Image size 2048x1536:
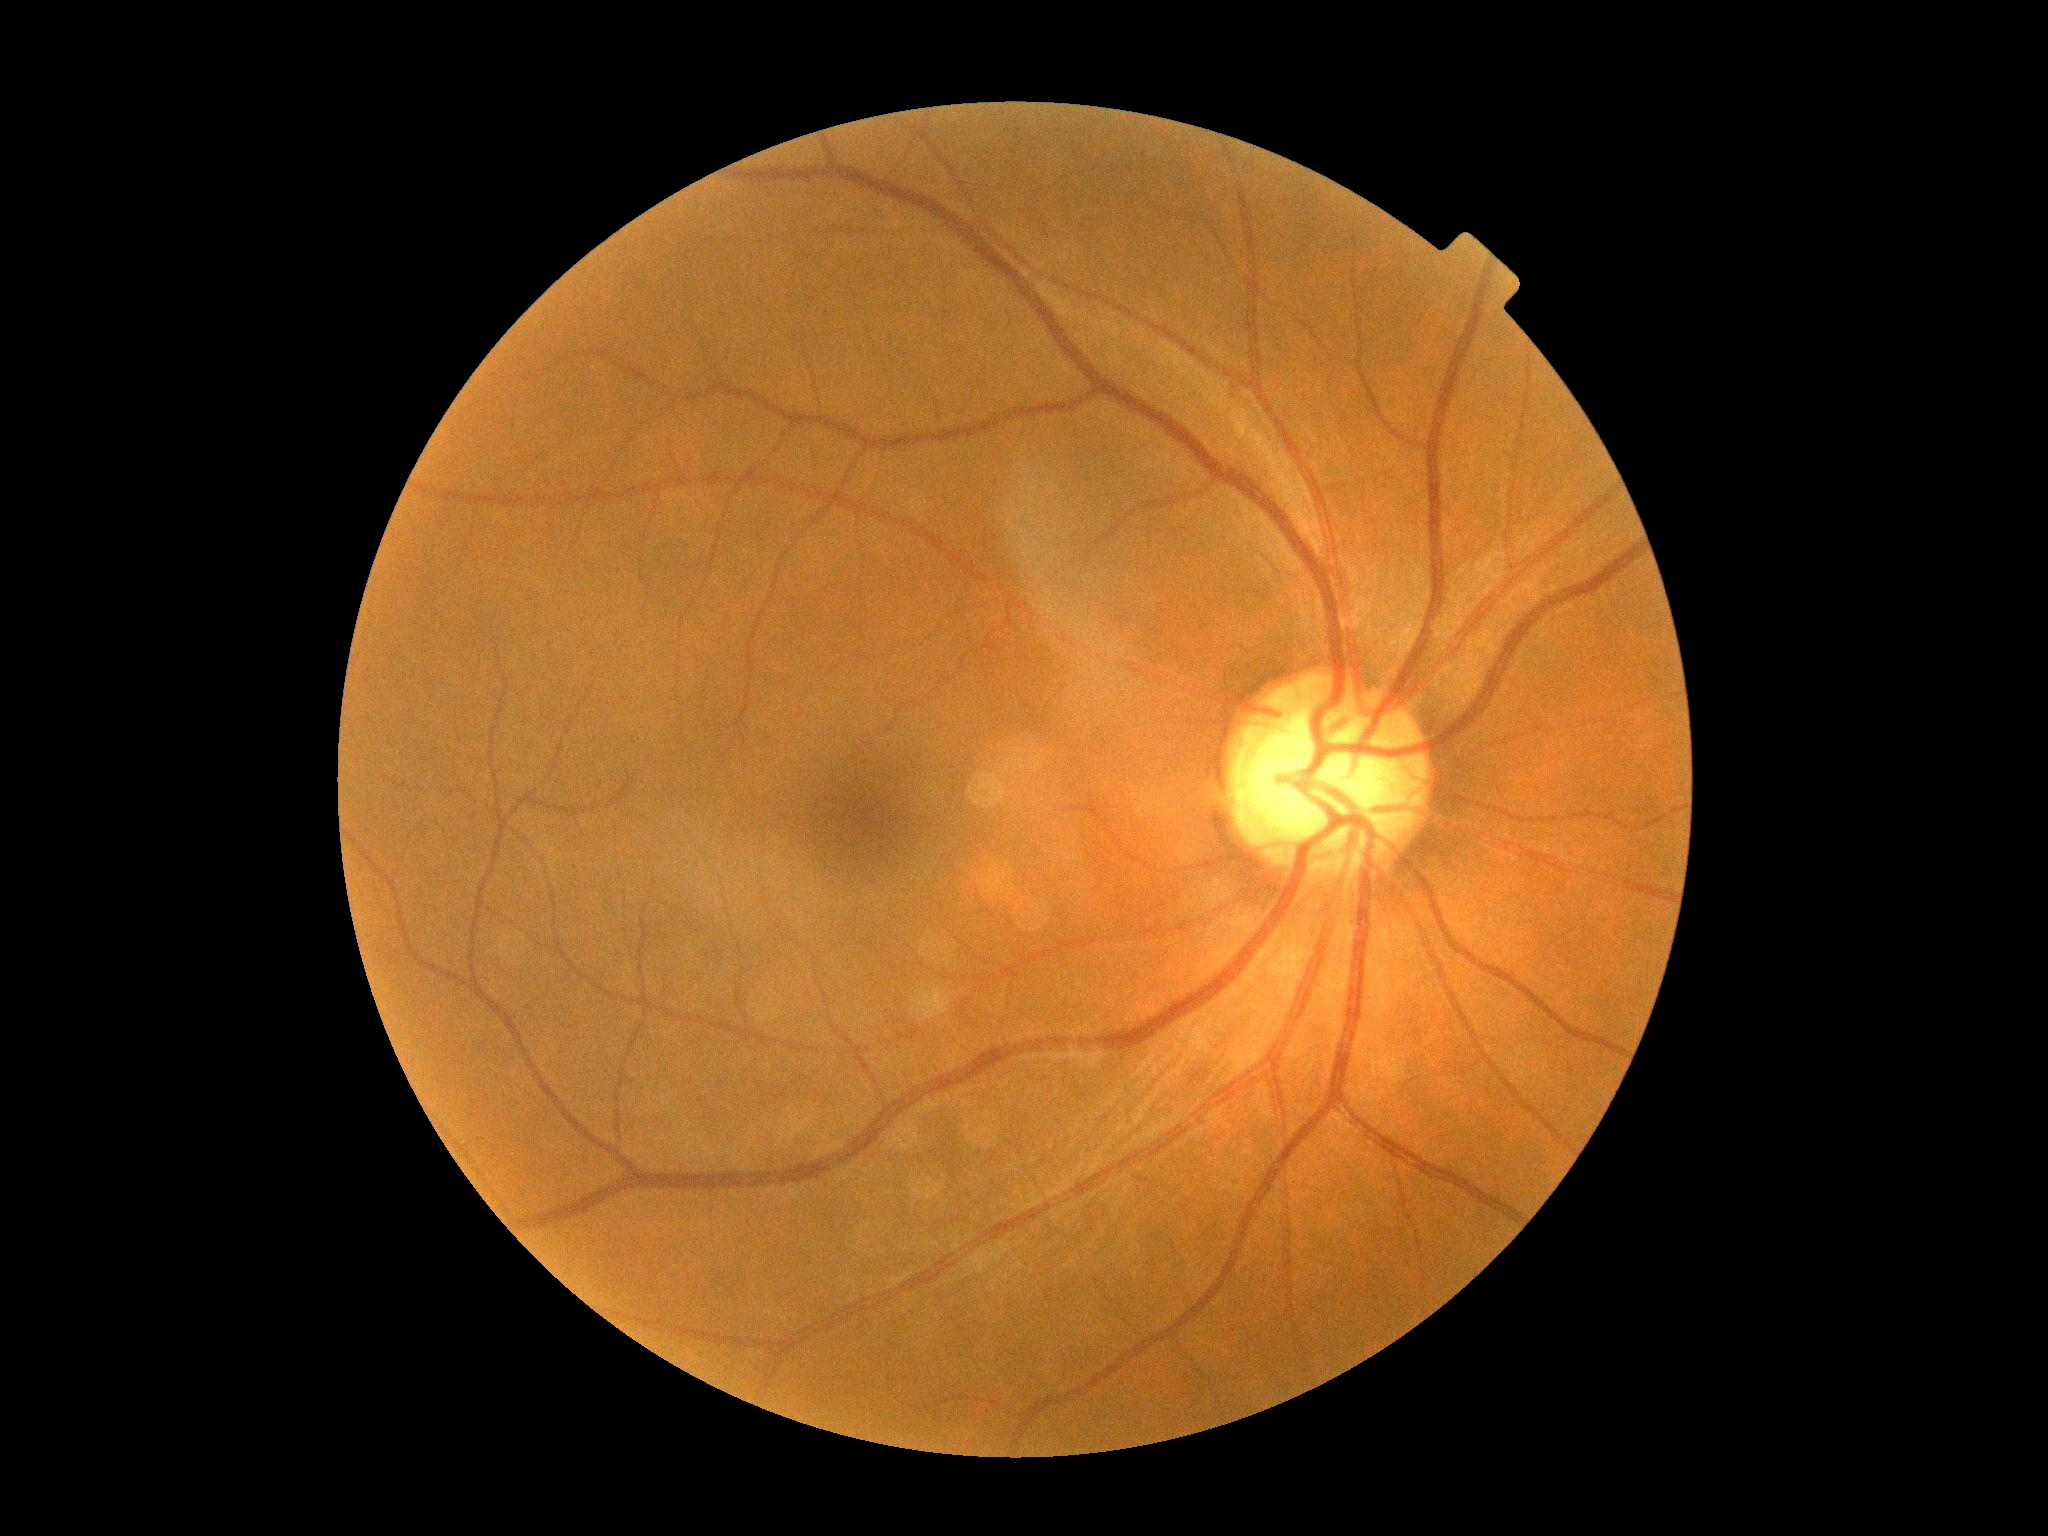

Retinopathy: 0/4.